Camera: Topcon TRC-50DX
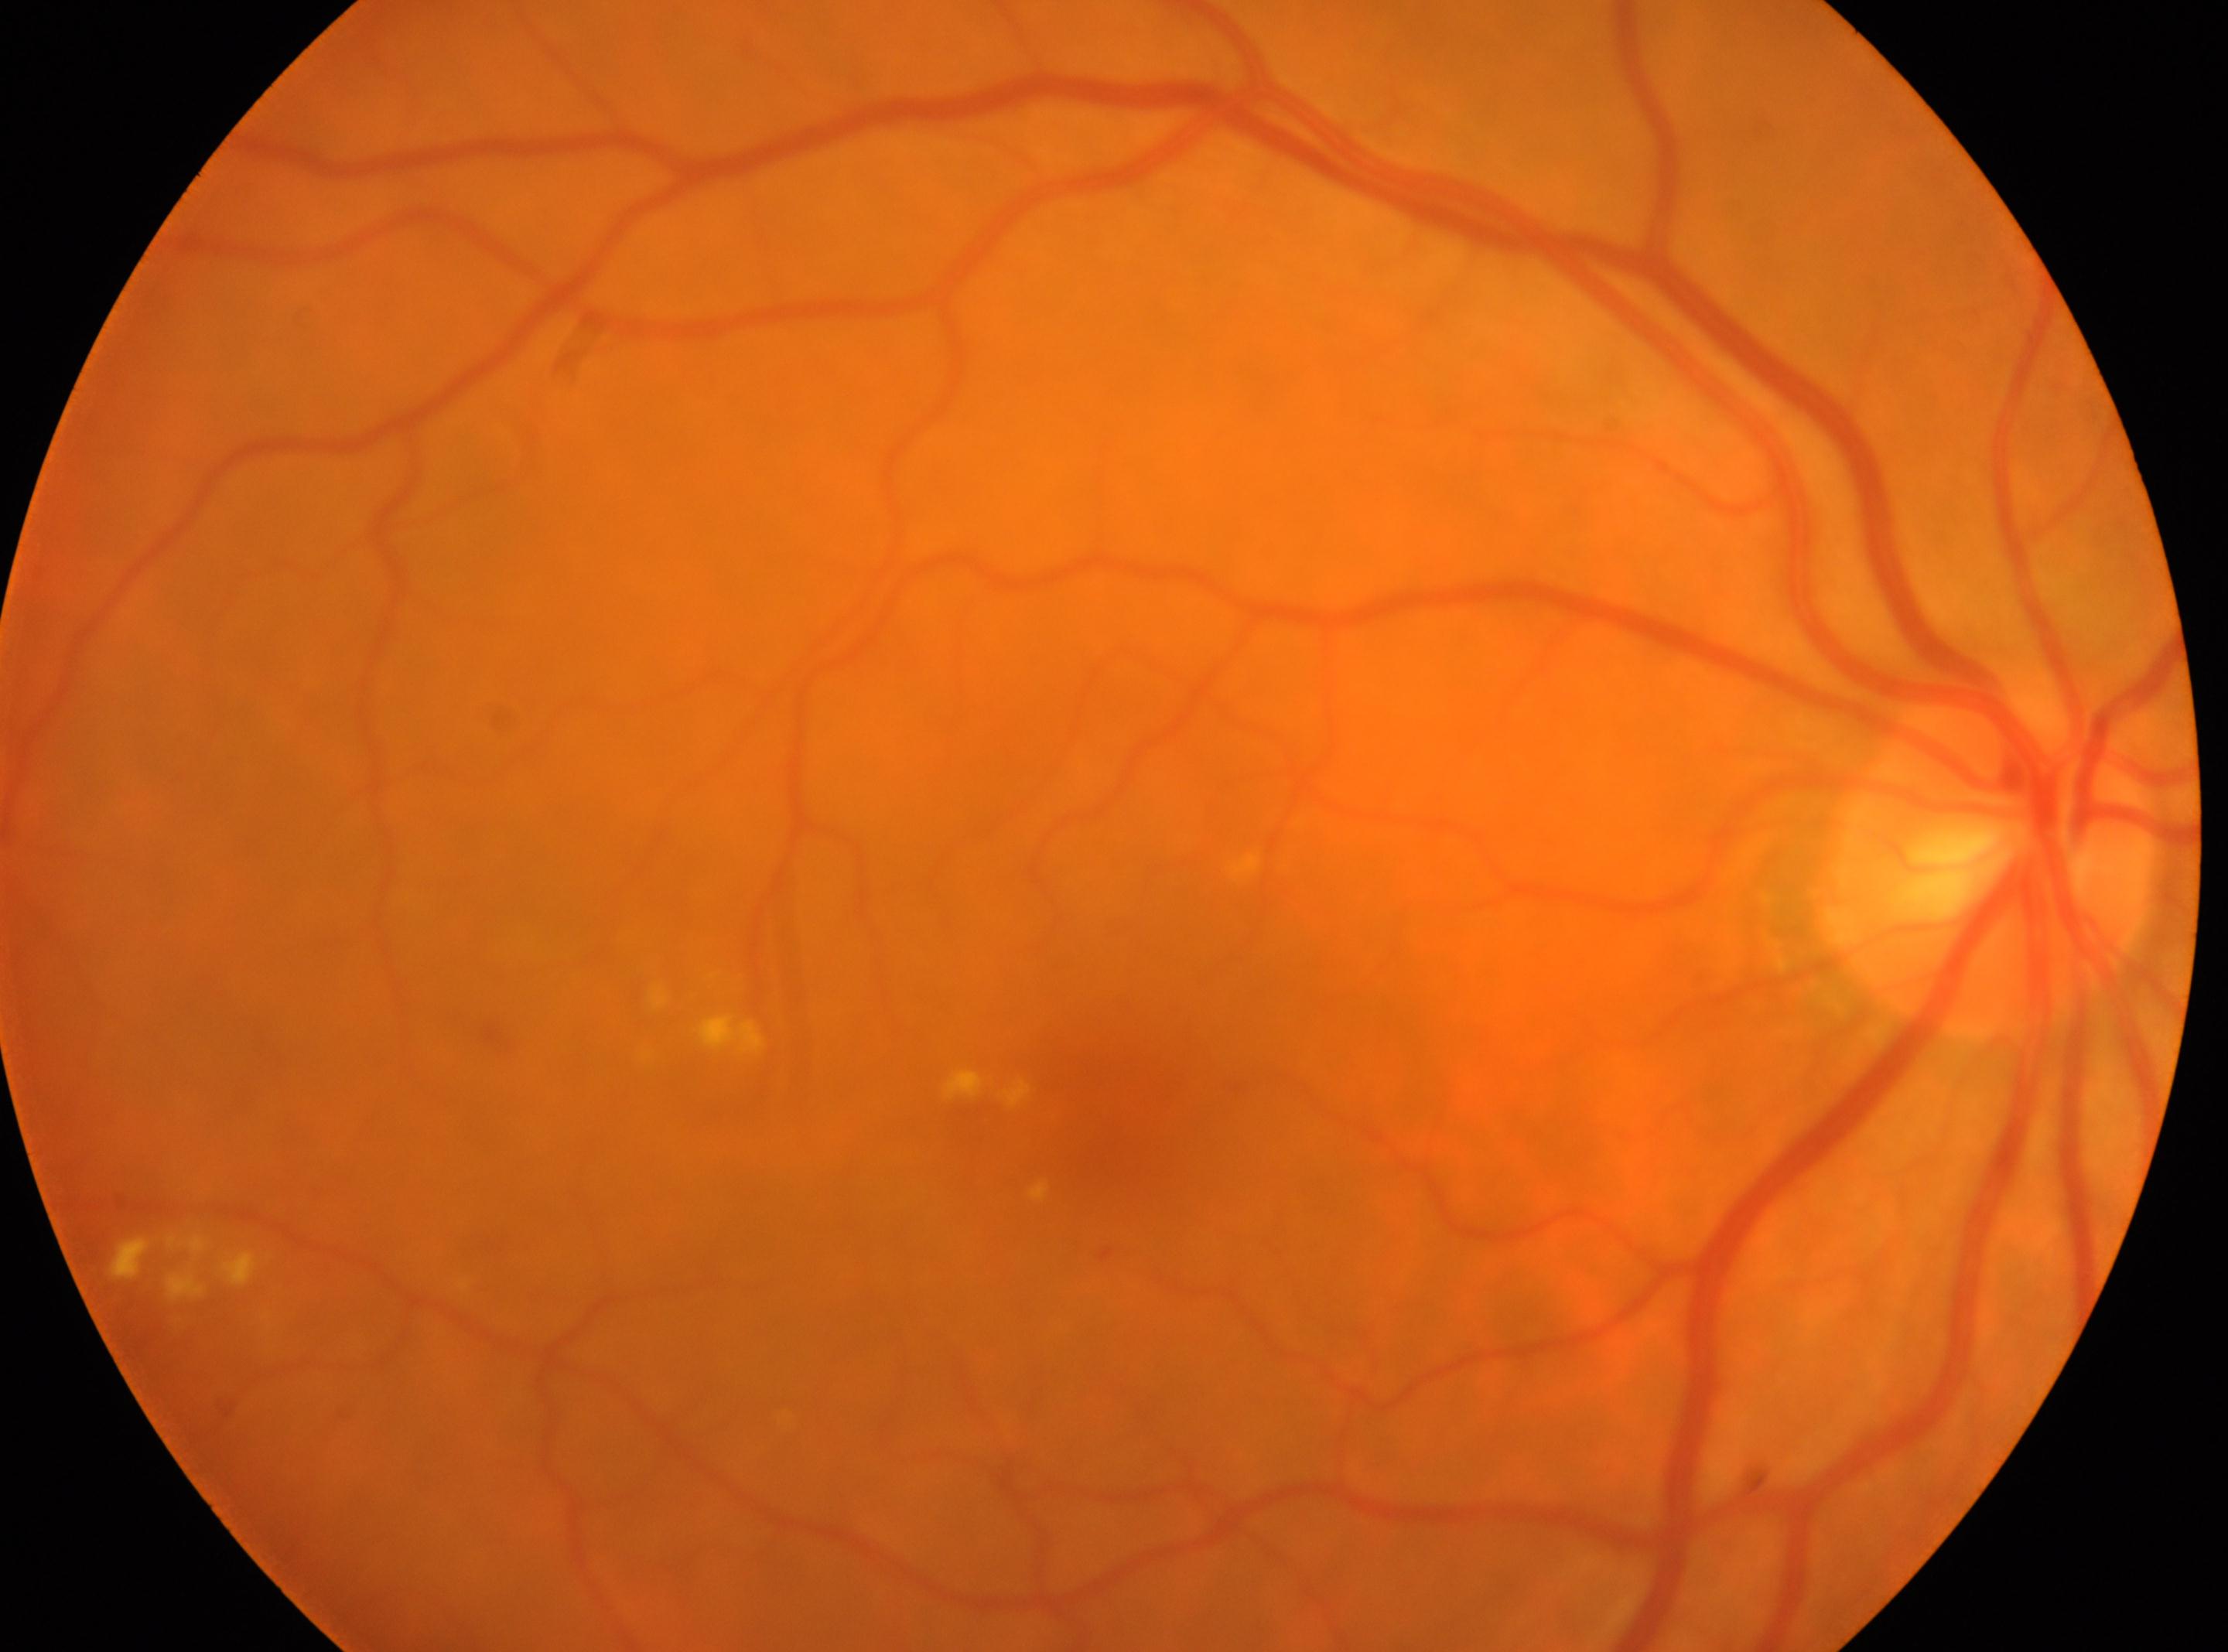
the optic disc: x=1991, y=869; macula center: x=1094, y=1121; diabetic retinopathy (DR): 2/4; eye: OD.